2352 x 1568 pixels · CFP · FOV: 45 degrees:
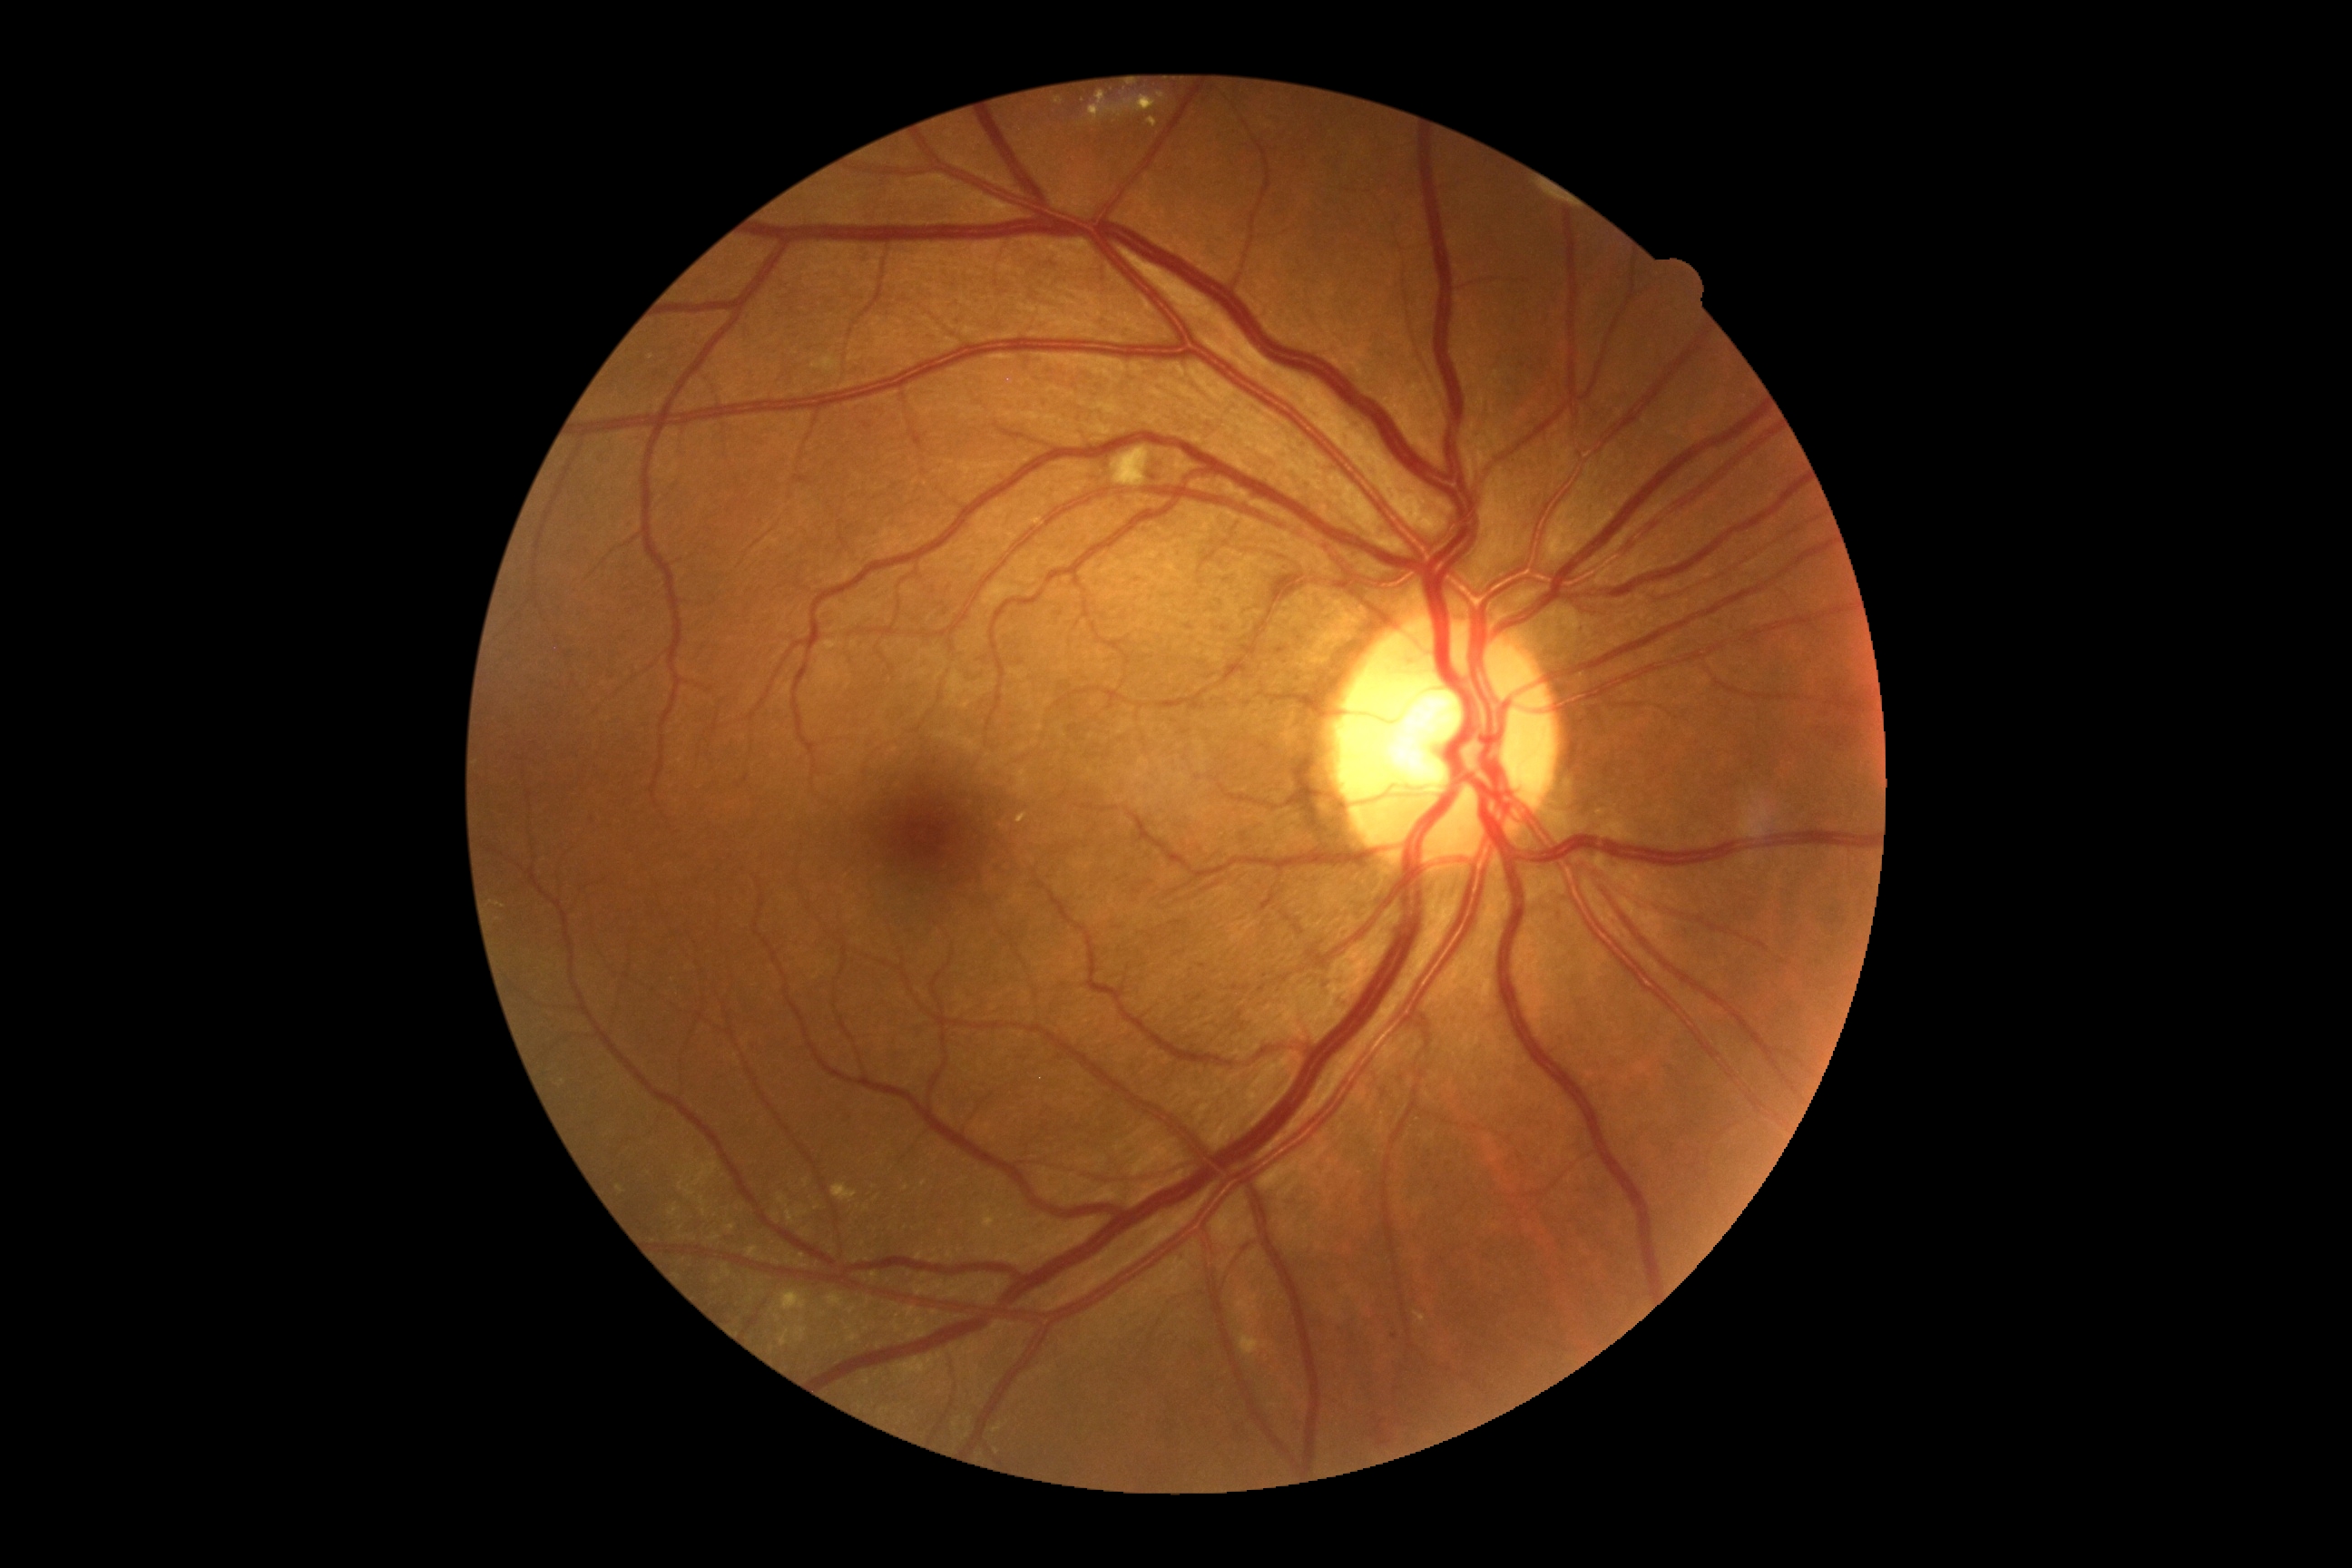
Diabetic retinopathy (DR): grade 2 — more than just microaneurysms but less than severe NPDR
Lesions identified (partial list):
soft exudates (SEs) = [1112, 447, 1150, 487]
hemorrhages (HEs) = none
Additional small MAs near 1020, 662 | 1395, 1337
hard exudates (EXs) = [832, 1184, 858, 1202] | [1148, 119, 1159, 128] | [1237, 1337, 1273, 1355] | [1157, 92, 1166, 101] | [796, 1326, 808, 1342] | [1055, 99, 1064, 104] | [779, 1329, 790, 1346] | [1088, 93, 1157, 124] | [779, 1291, 808, 1311] | [983, 1211, 997, 1230] | [749, 1246, 767, 1260] | [1415, 1313, 1427, 1326]